Acquired with a NIDEK AFC-230, color fundus photograph, no pharmacologic dilation, 45° field of view
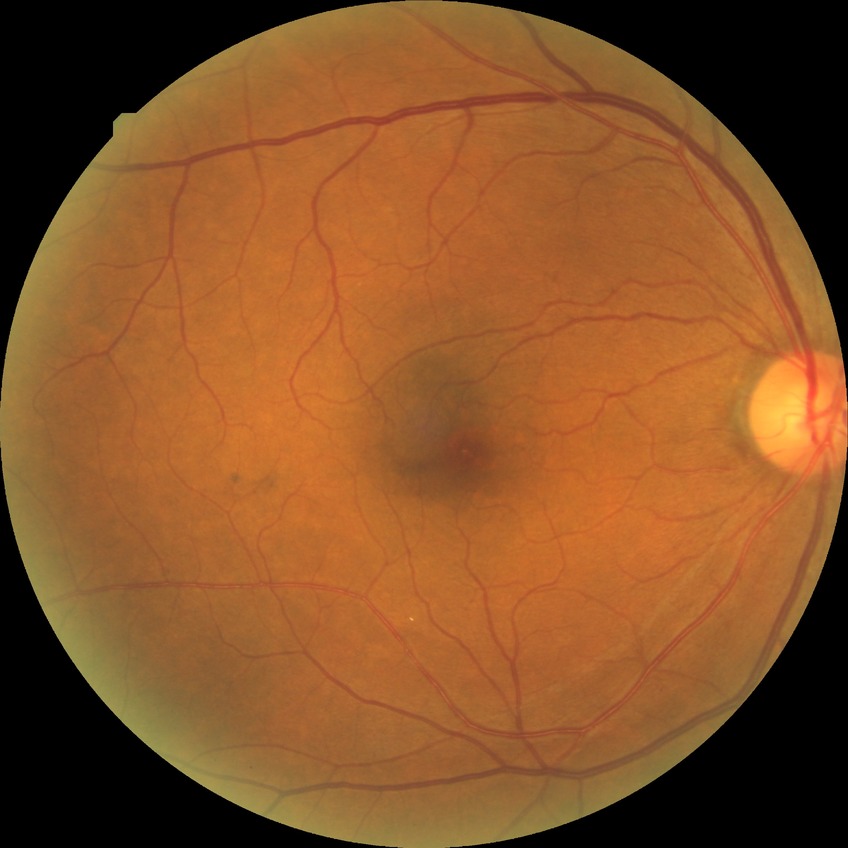

* diabetic retinopathy (DR): NDR (no diabetic retinopathy)